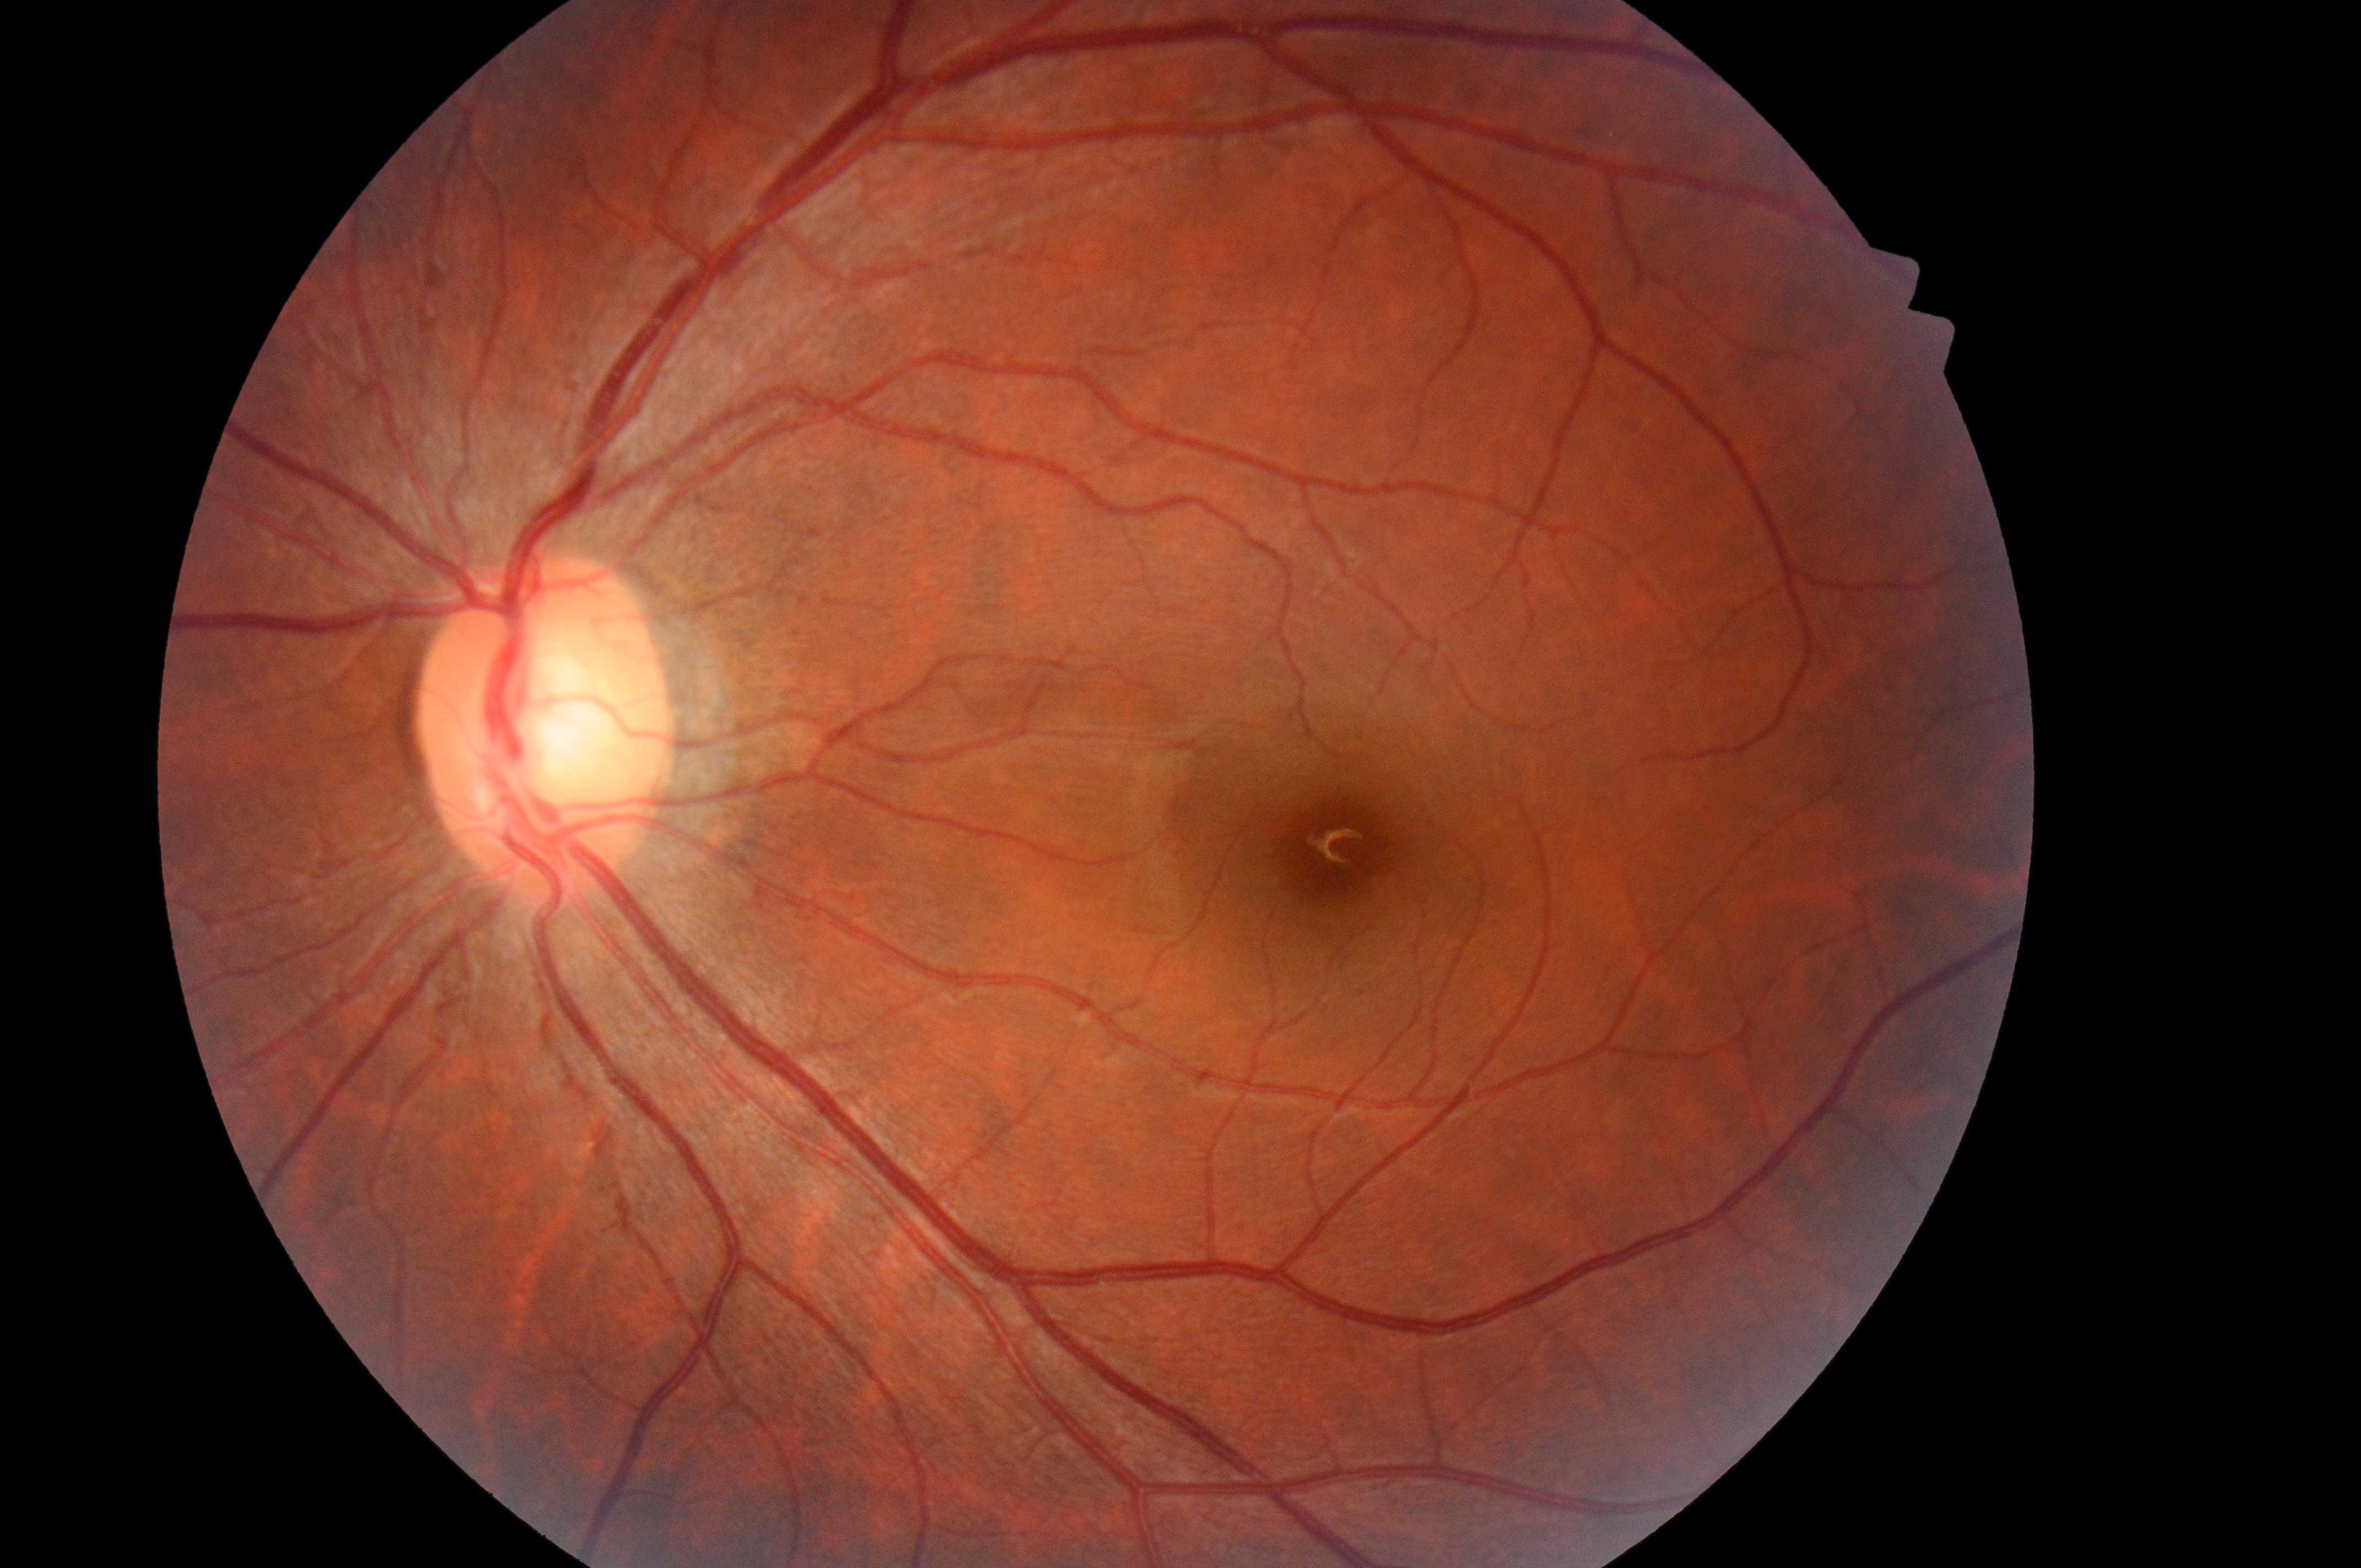 Diabetic macular edema (DME) is 0/2. Imaged eye: left eye. Optic disc located at (542,740). Macula center located at (1339,845). Diabetic retinopathy (DR) is grade 0. No signs of diabetic retinopathy or diabetic macular edema.